RetCam wide-field infant fundus image. Image size 640x480:
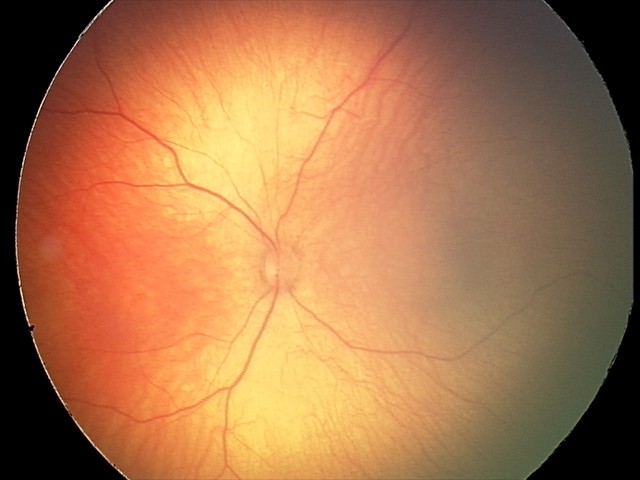

Physiological retinal appearance for postconceptual age.